Tabletop color fundus camera image — 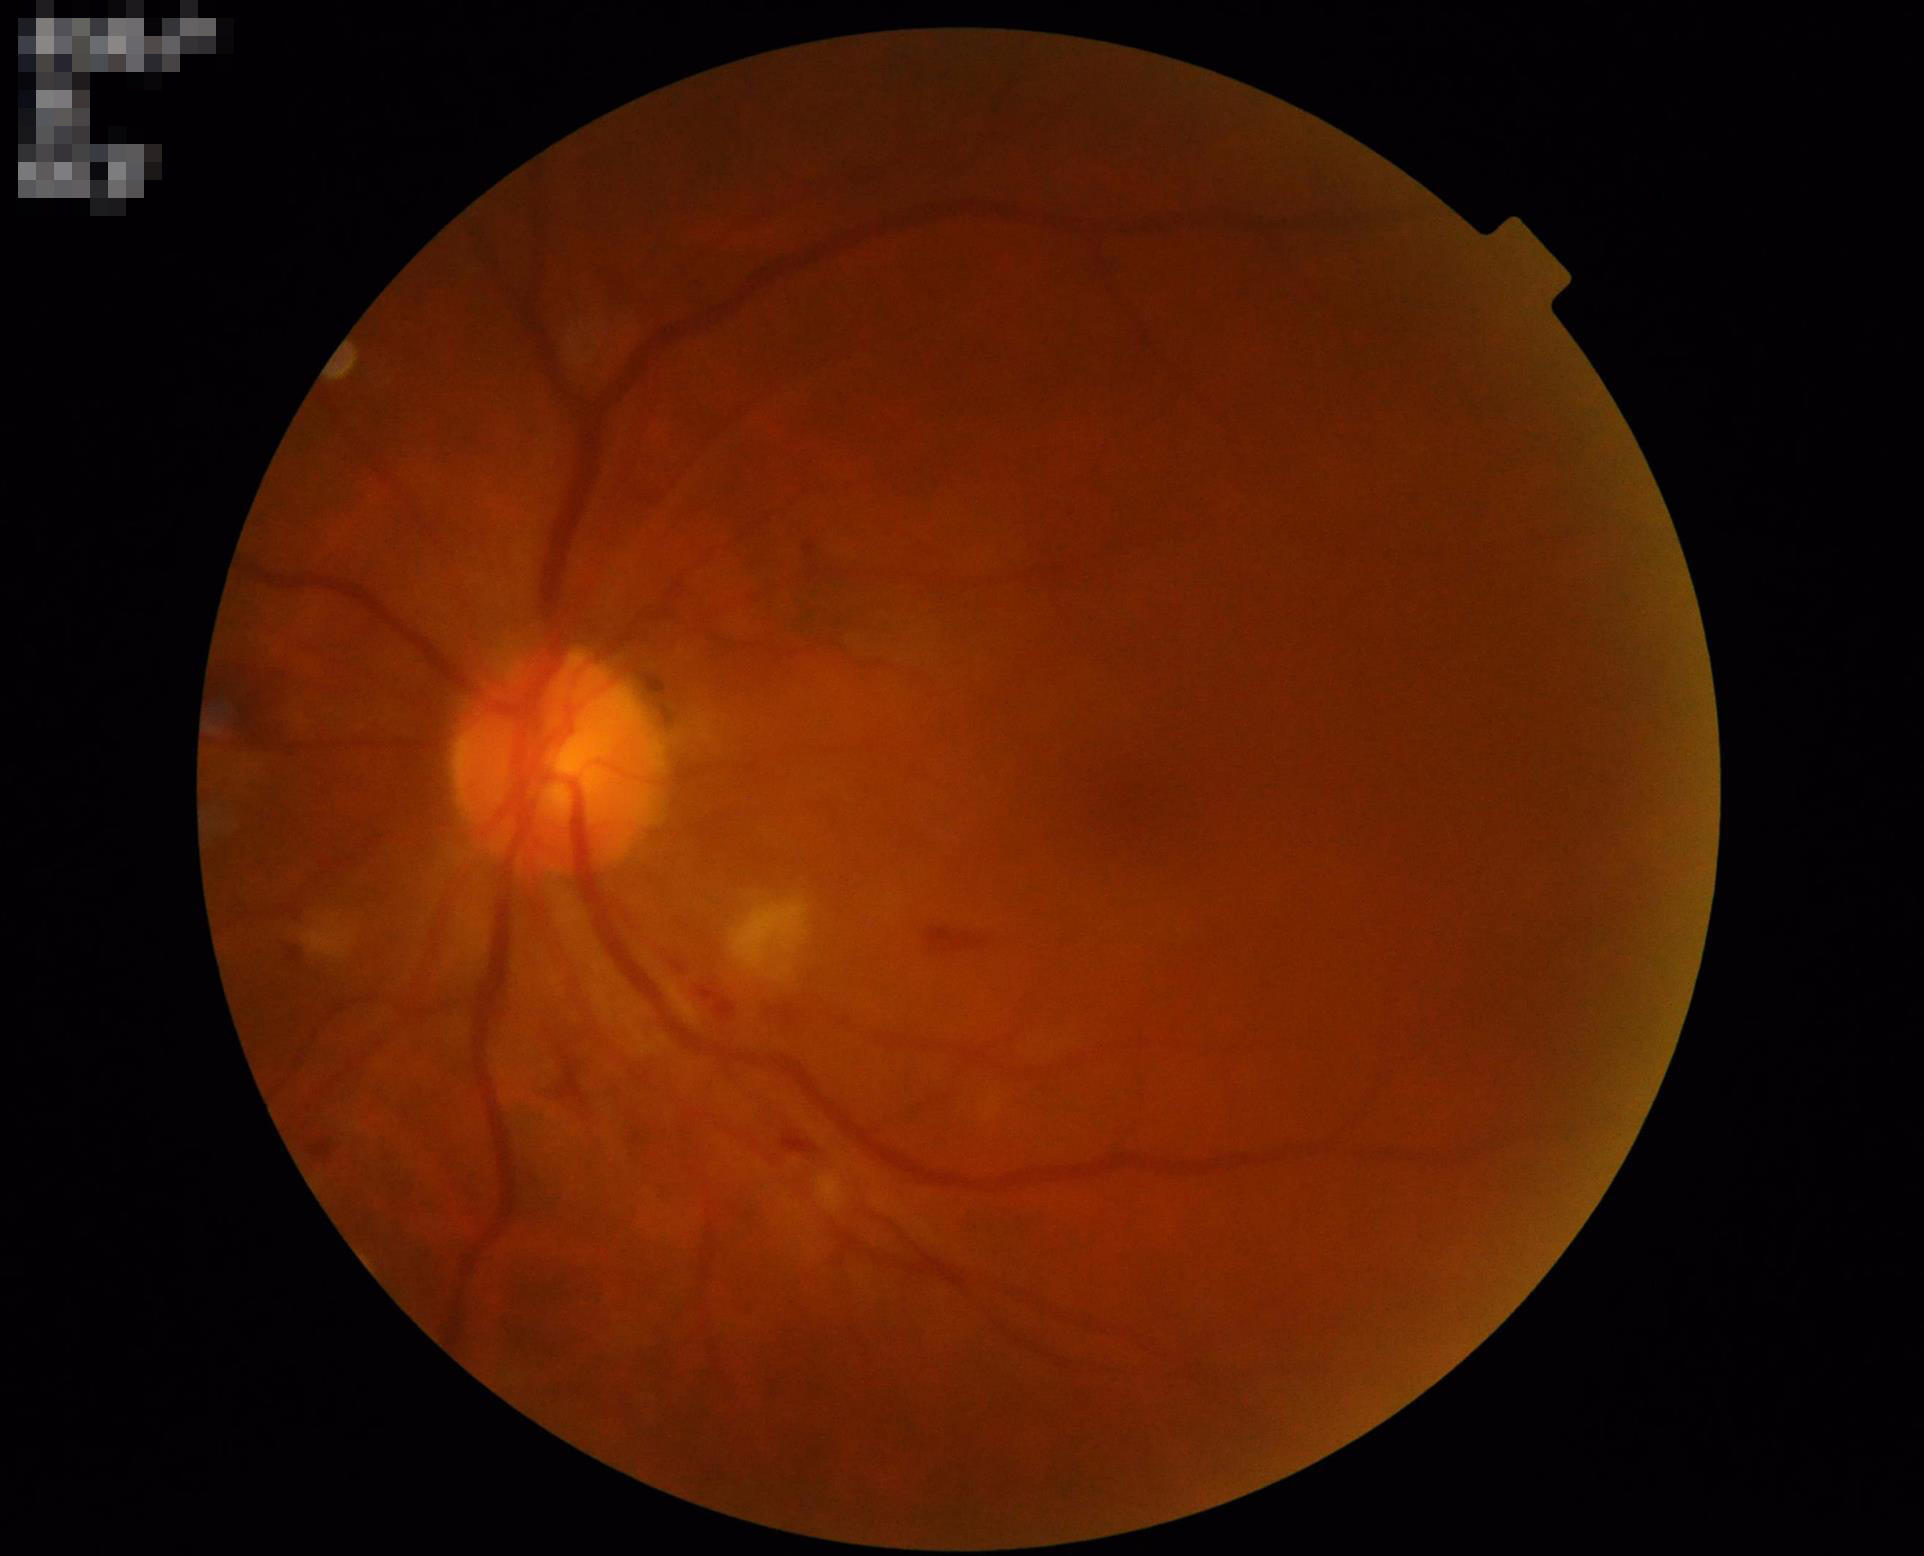 Image quality: illumination/color: satisfactory; focus: blurry; contrast: satisfactory; overall: low.